2212x1659px:
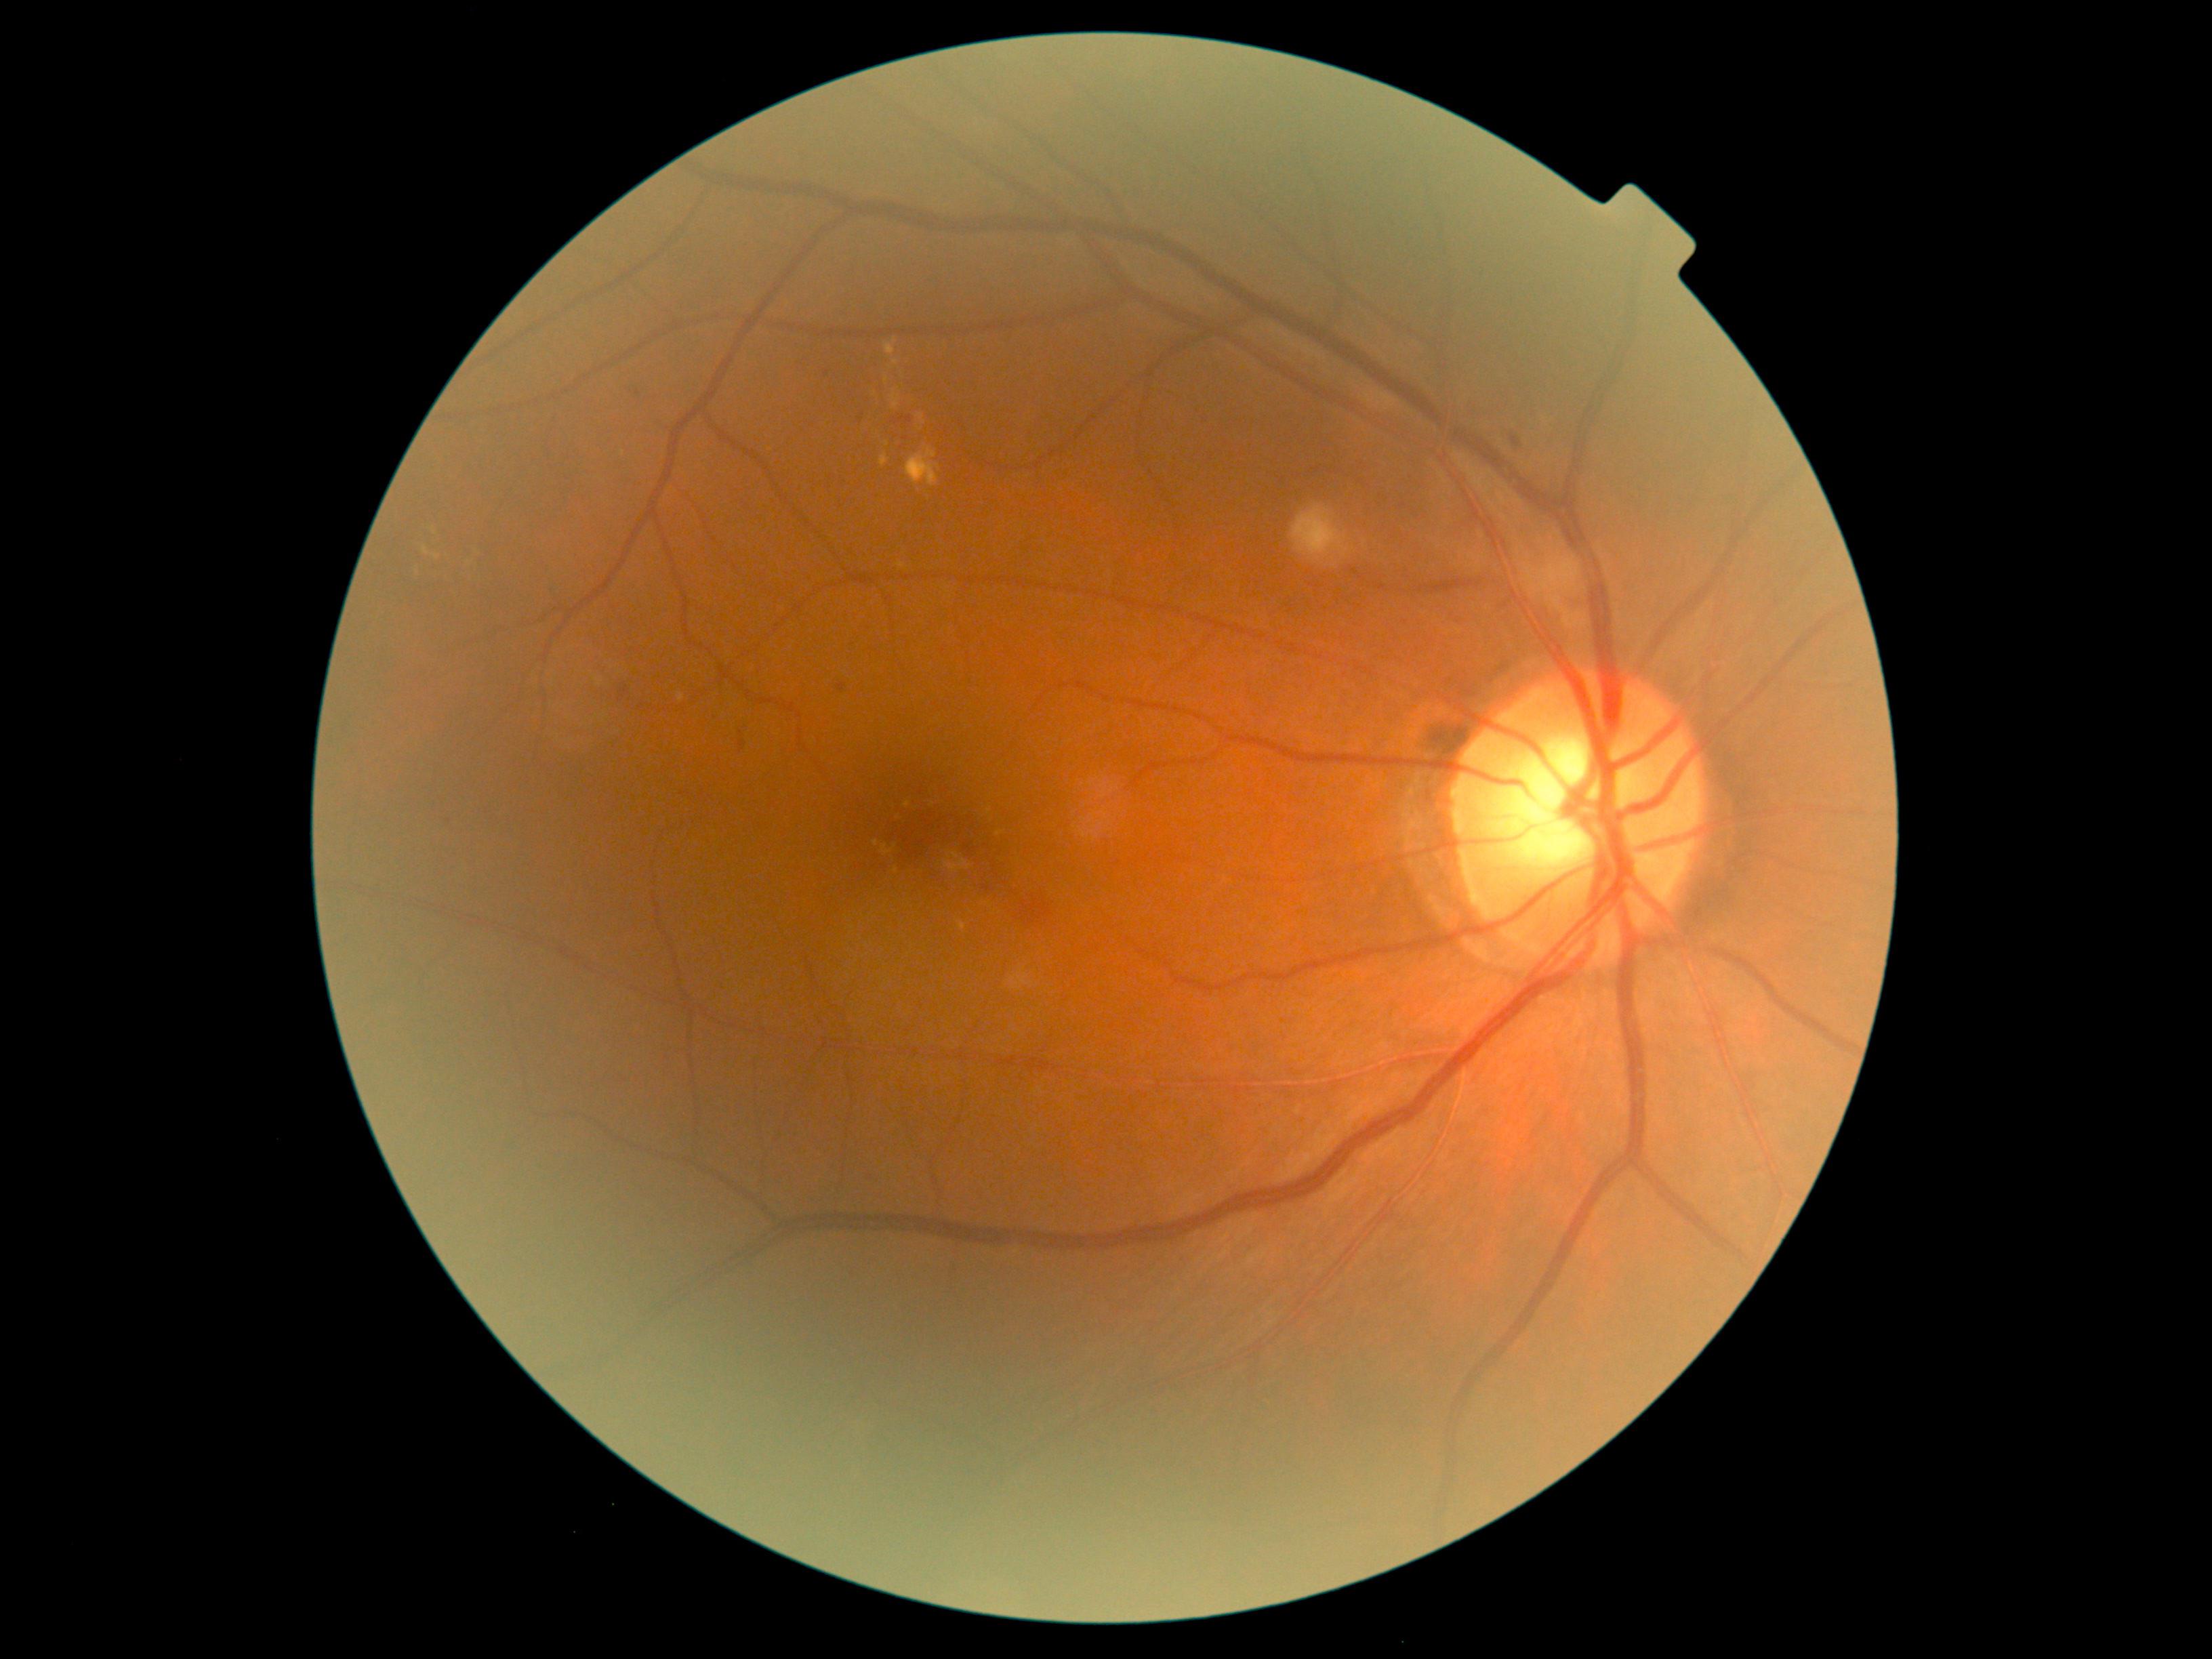

dr_grade: grade 2 (moderate NPDR)